Undilated pupil; color fundus photograph:
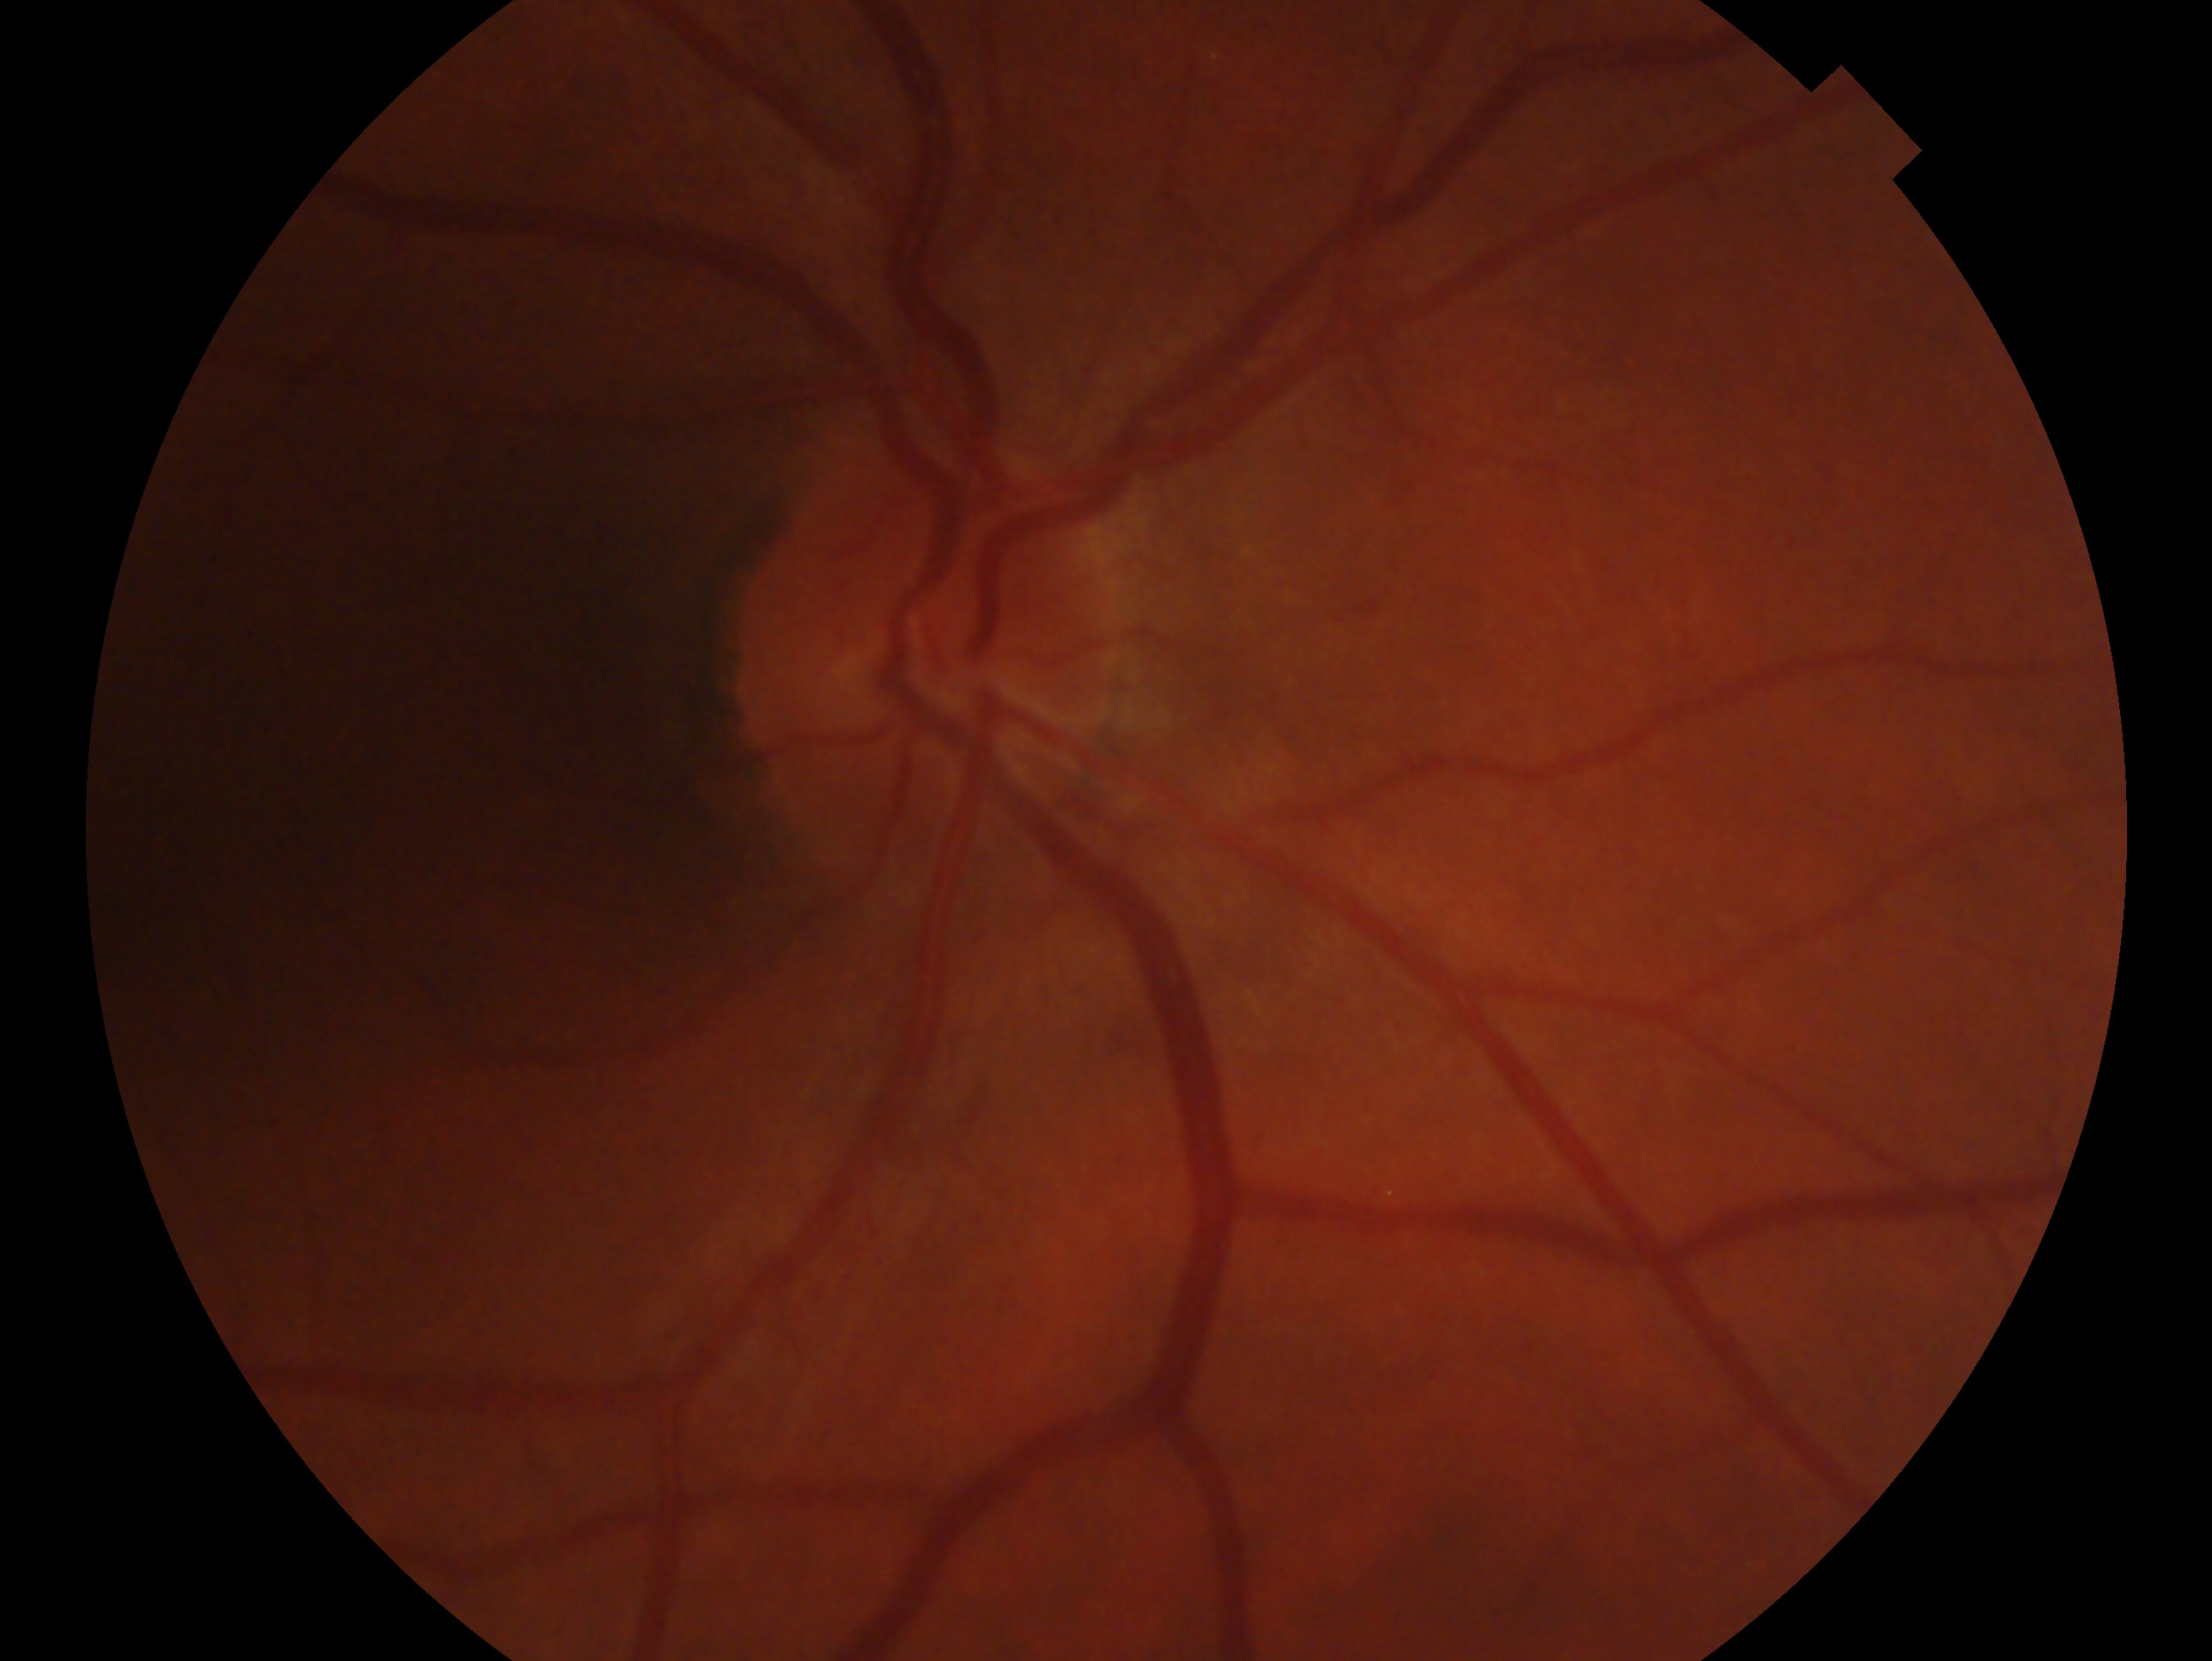

Impression — no signs of glaucoma.
This is the OD.